Acquired with a Nidek AFC-330:
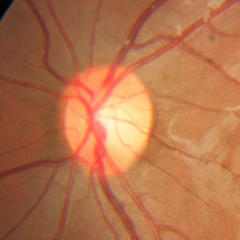

Glaucoma status = no glaucomatous optic neuropathy.